Clarity RetCam 3, 130° FOV; wide-field fundus photograph of an infant
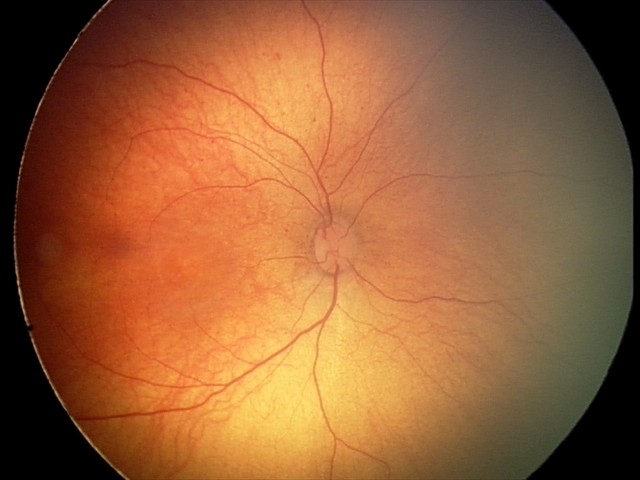

Normal screening examination.